Nonmydriatic:
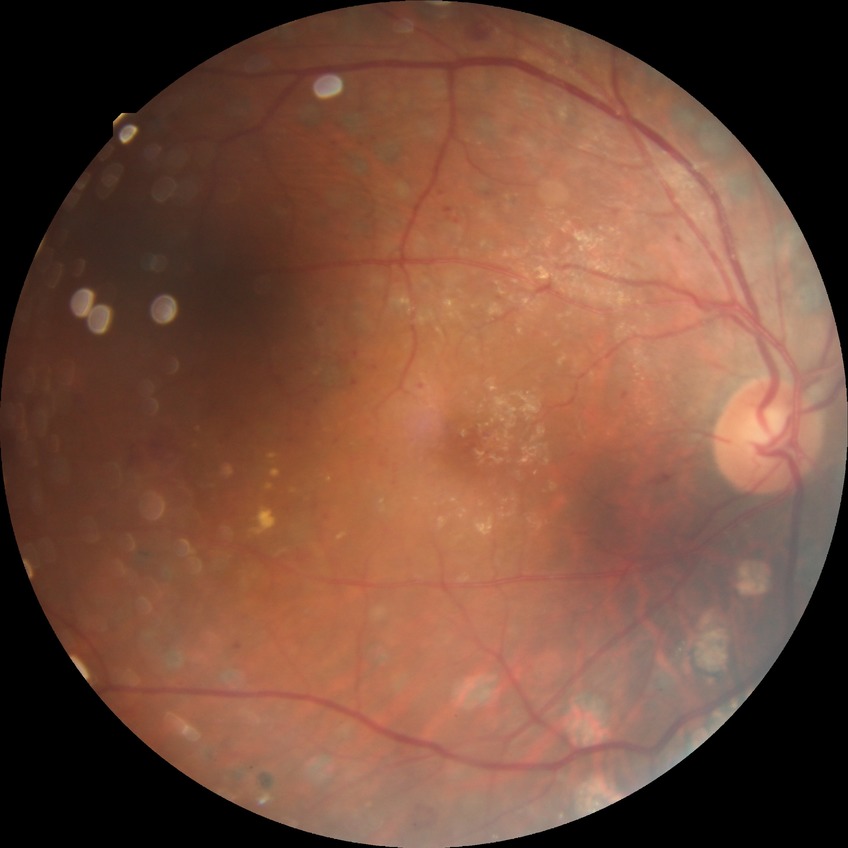 diabetic retinopathy (DR)@proliferative diabetic retinopathy (PDR).